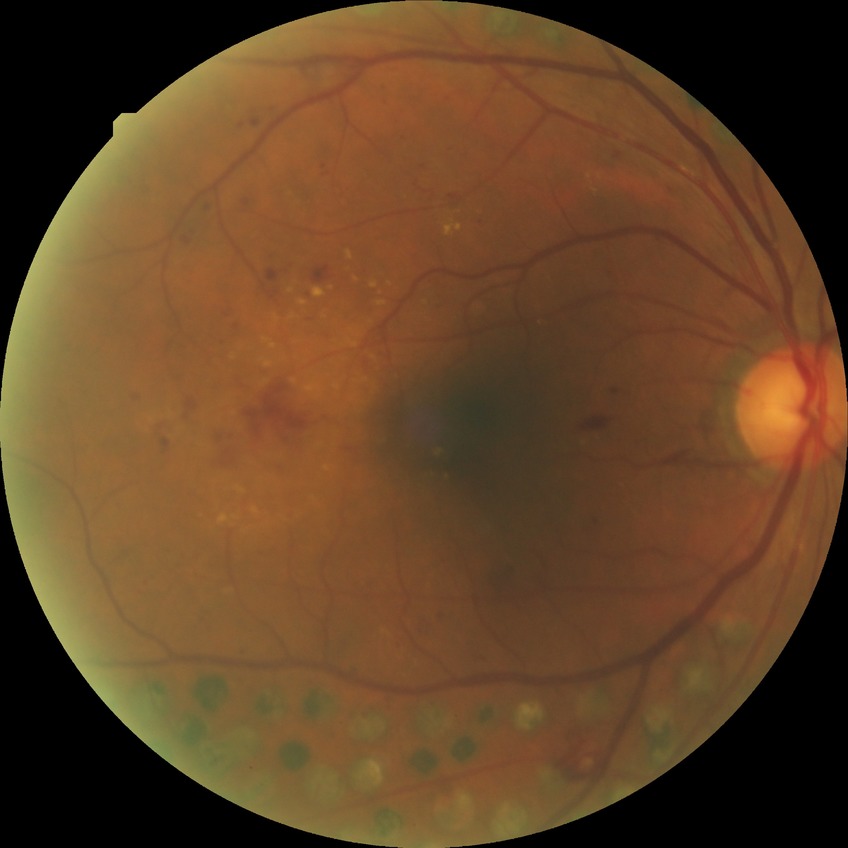 Retinopathy grade: proliferative diabetic retinopathy.